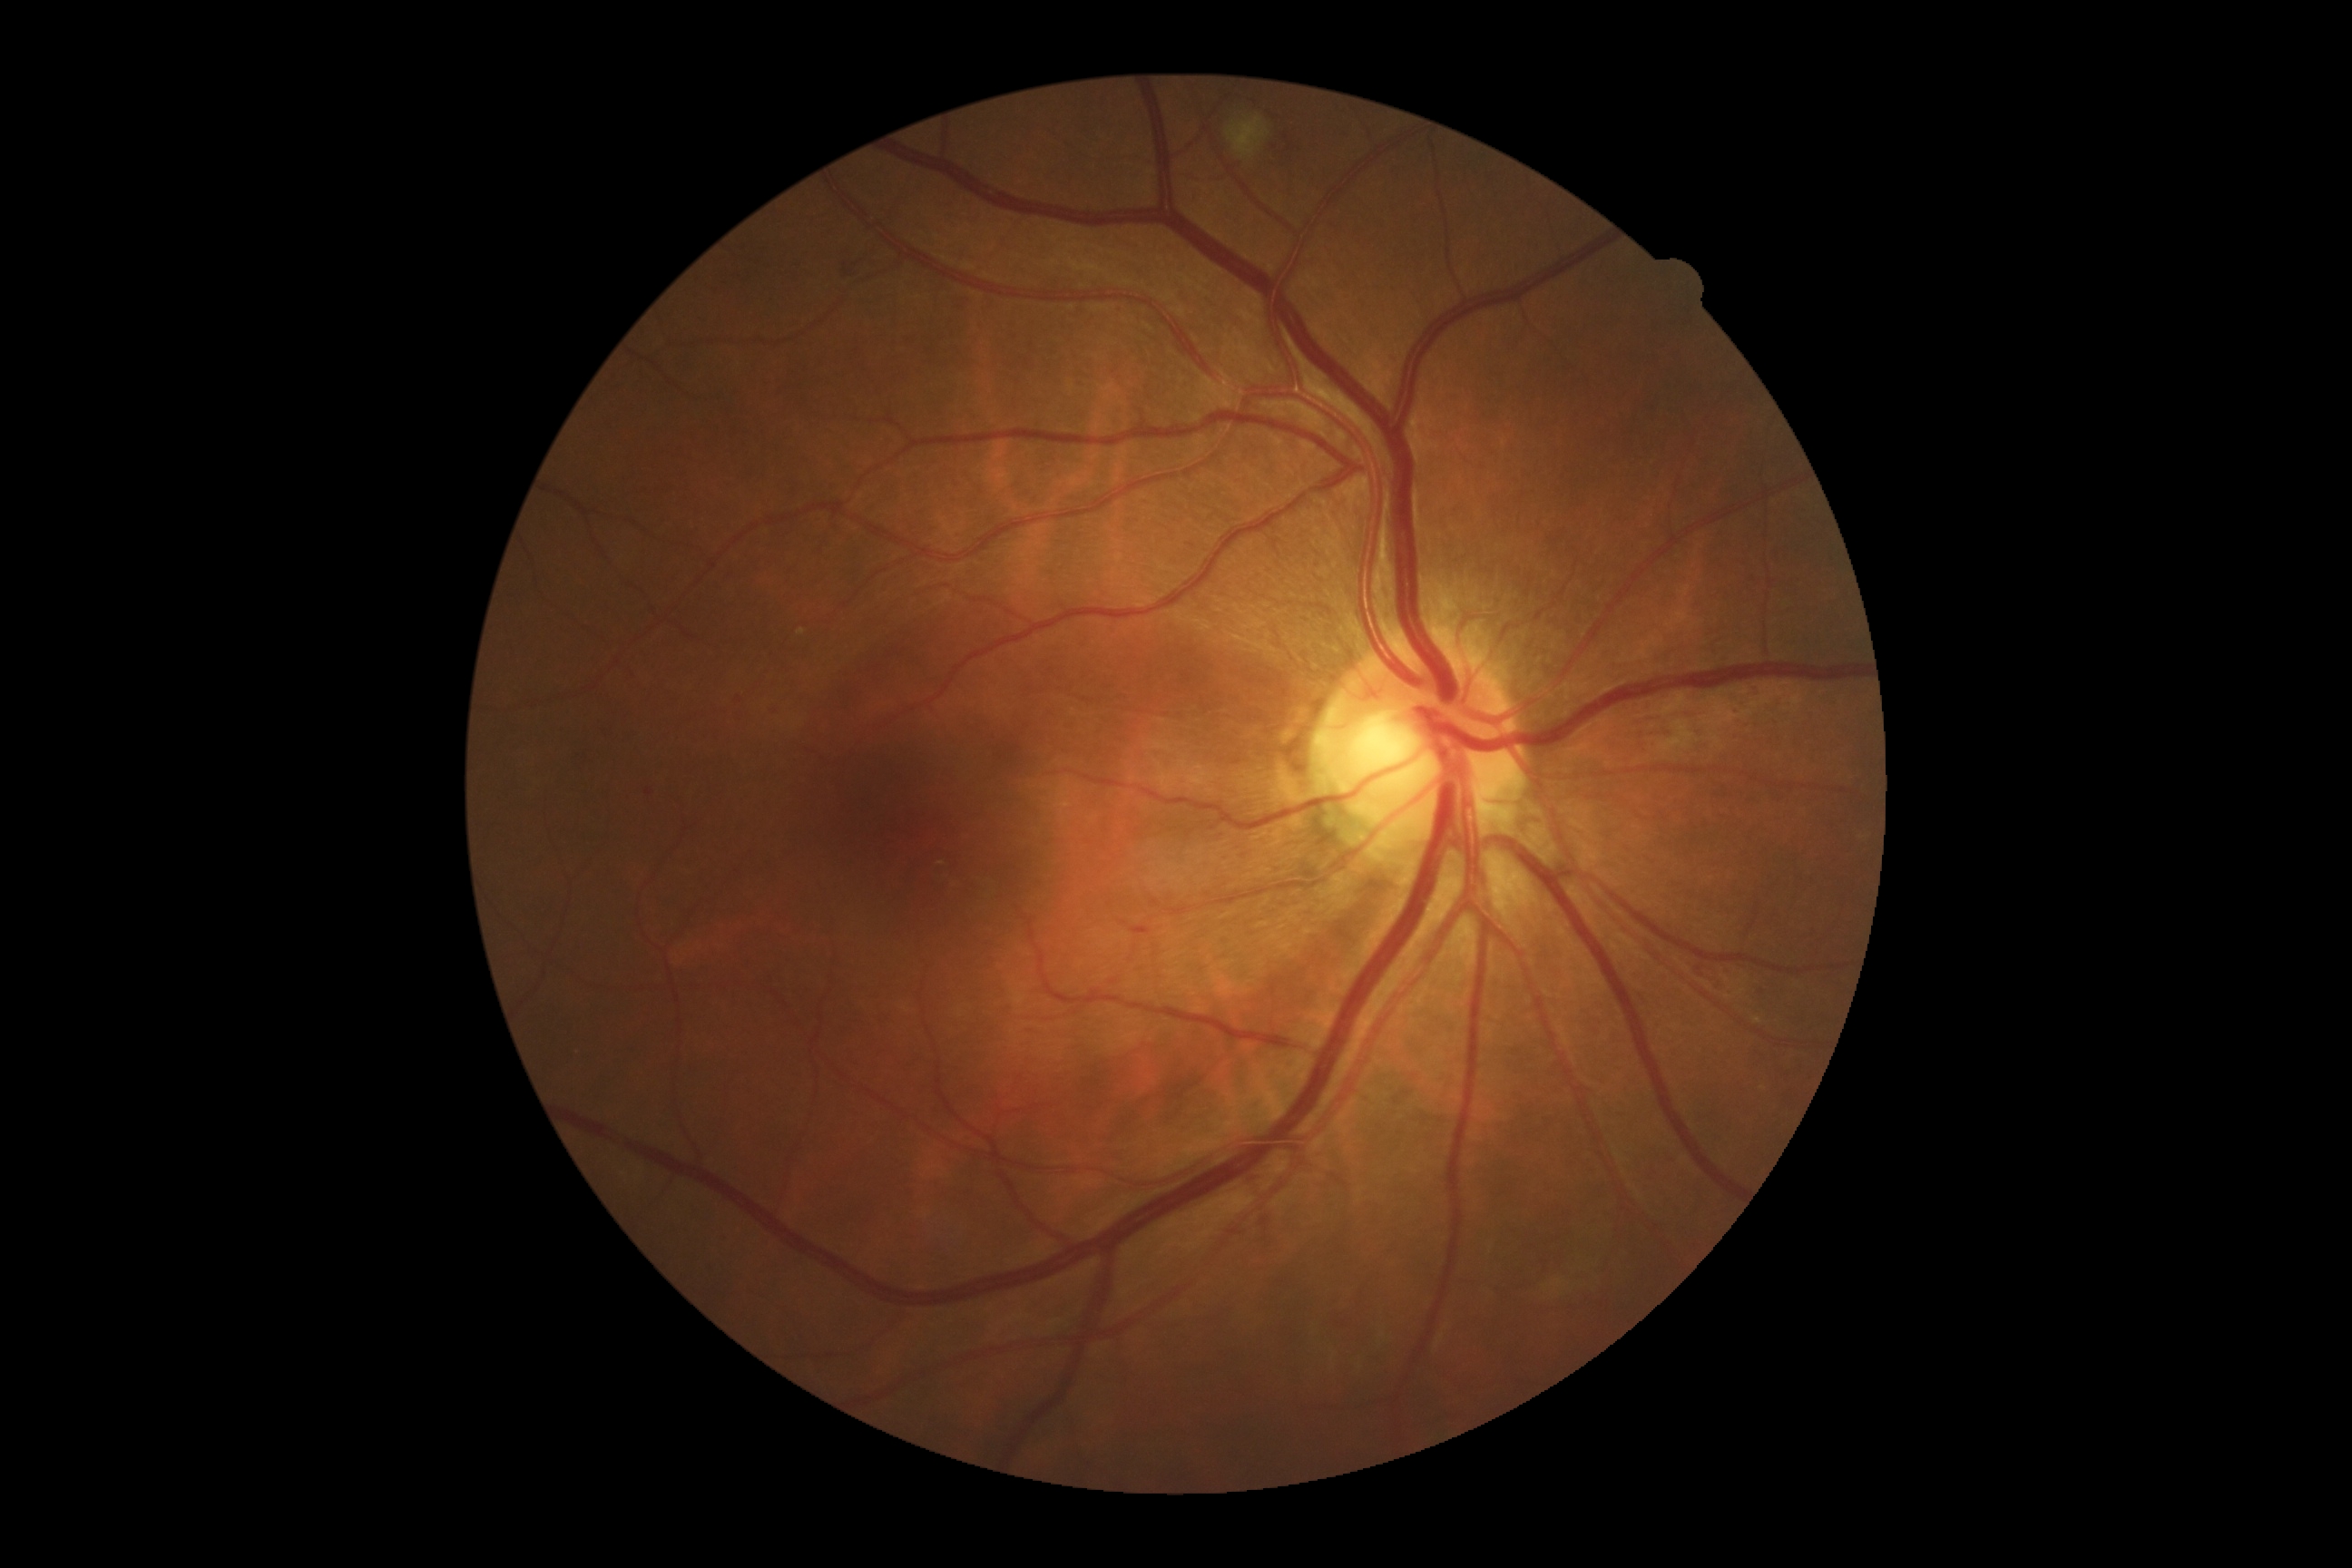
DR severity: grade 2 (moderate NPDR).